Graded on the modified Davis scale: 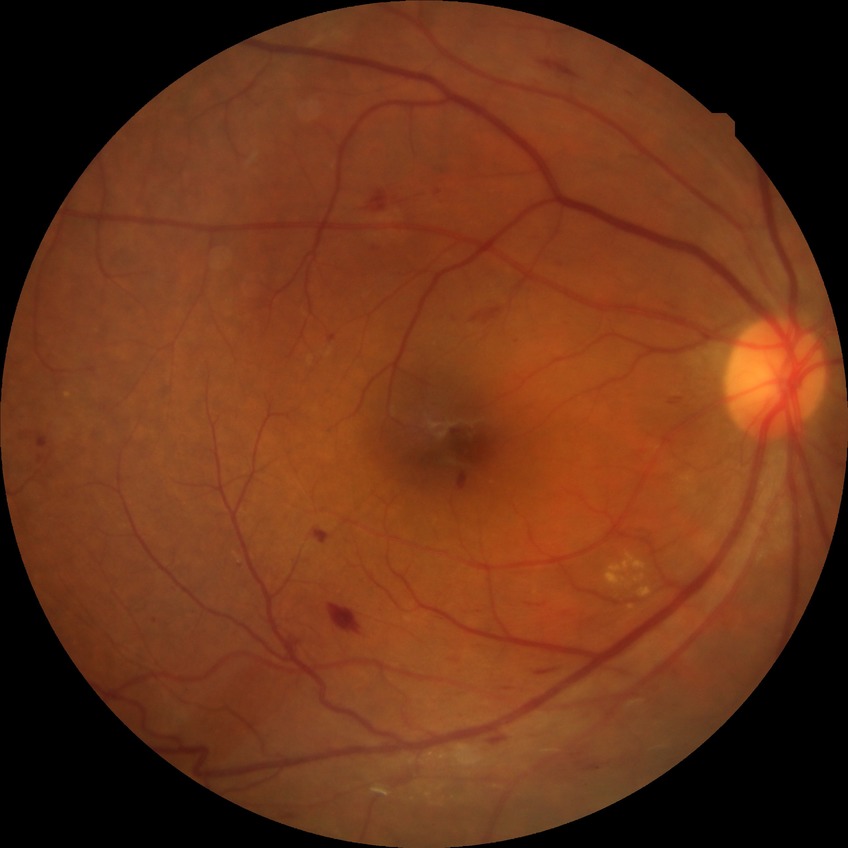

  davis_grade: simple diabetic retinopathy (SDR)